Pediatric retinal photograph (wide-field) · 1240x1240
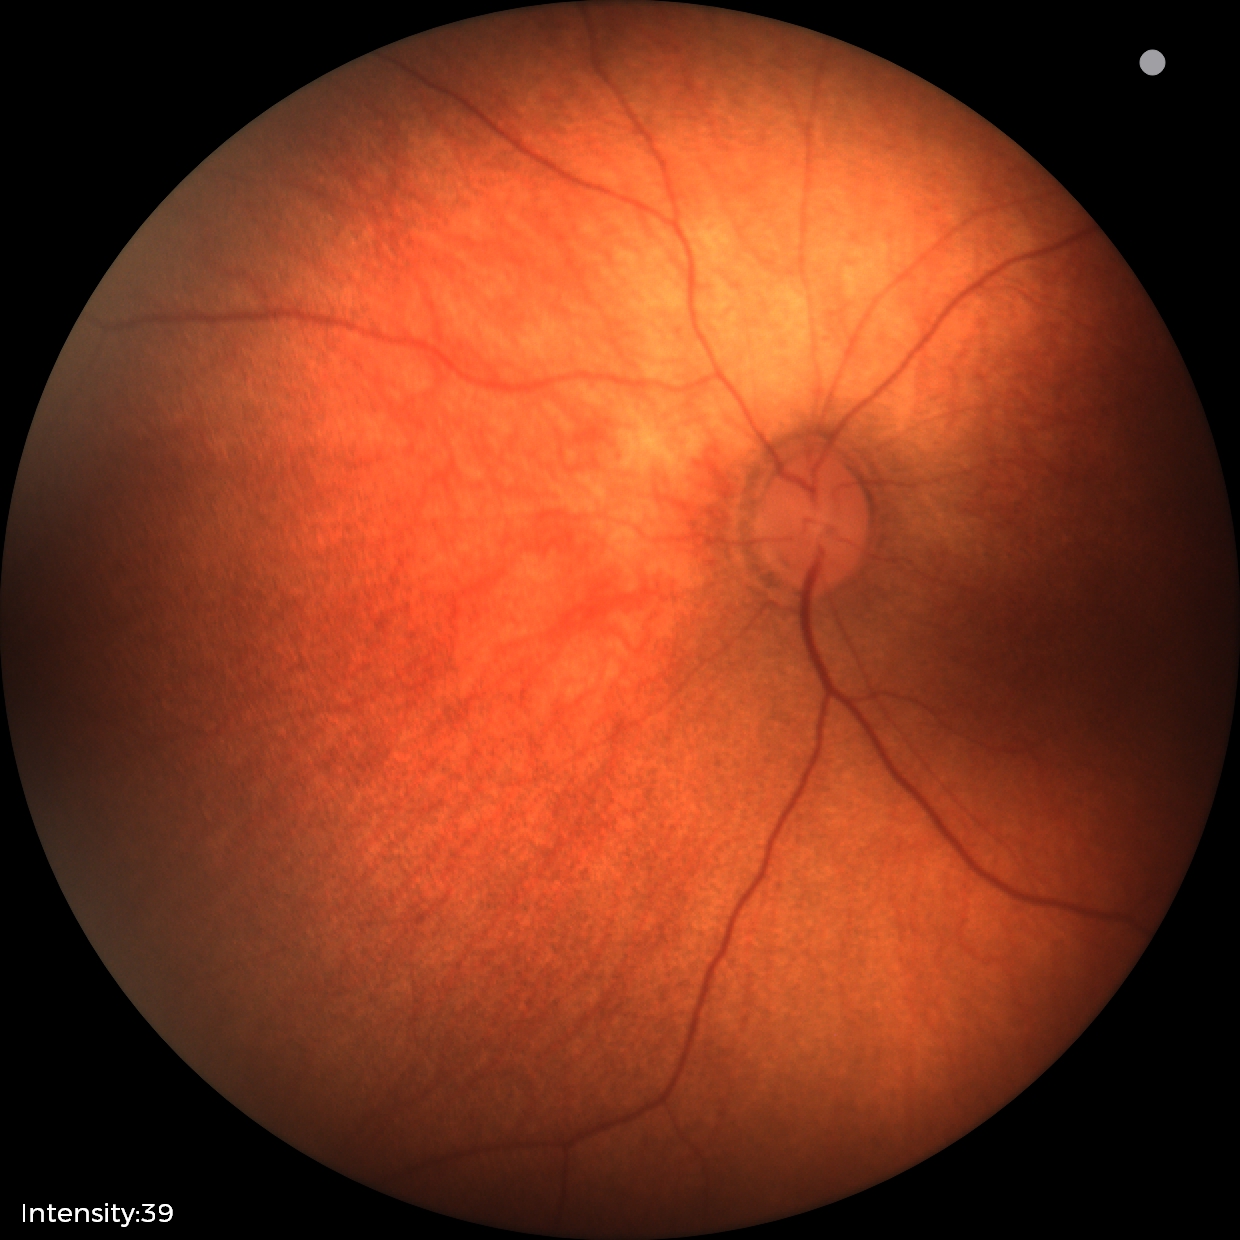 Finding: no abnormalities.